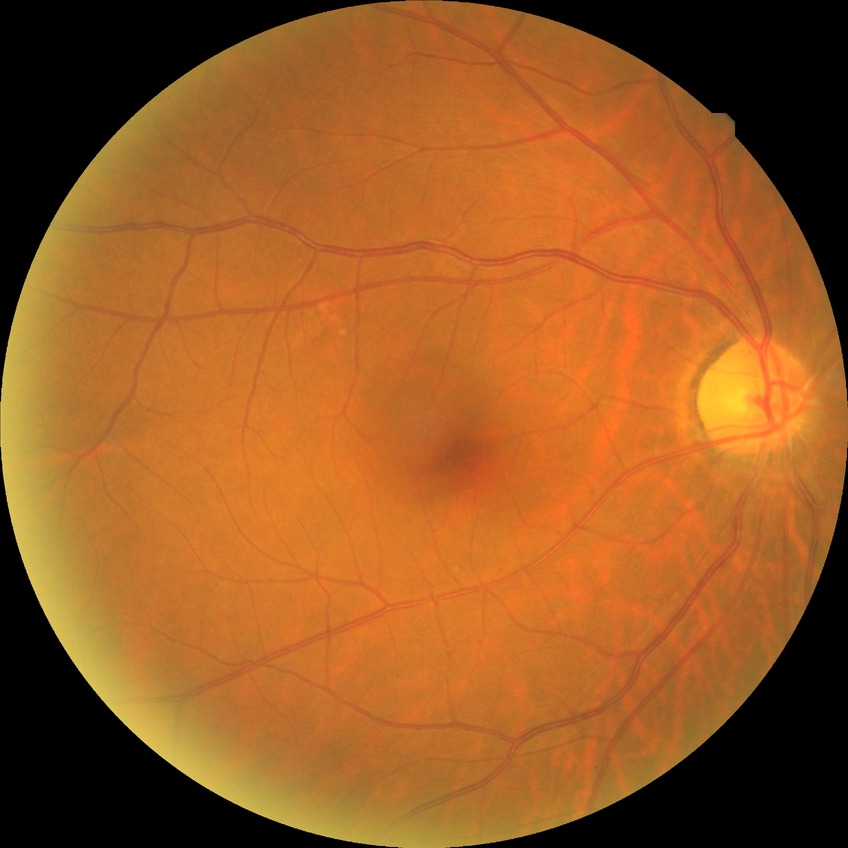
DR grade is NDR.